Image size 1240x1240 · pediatric wide-field fundus photograph
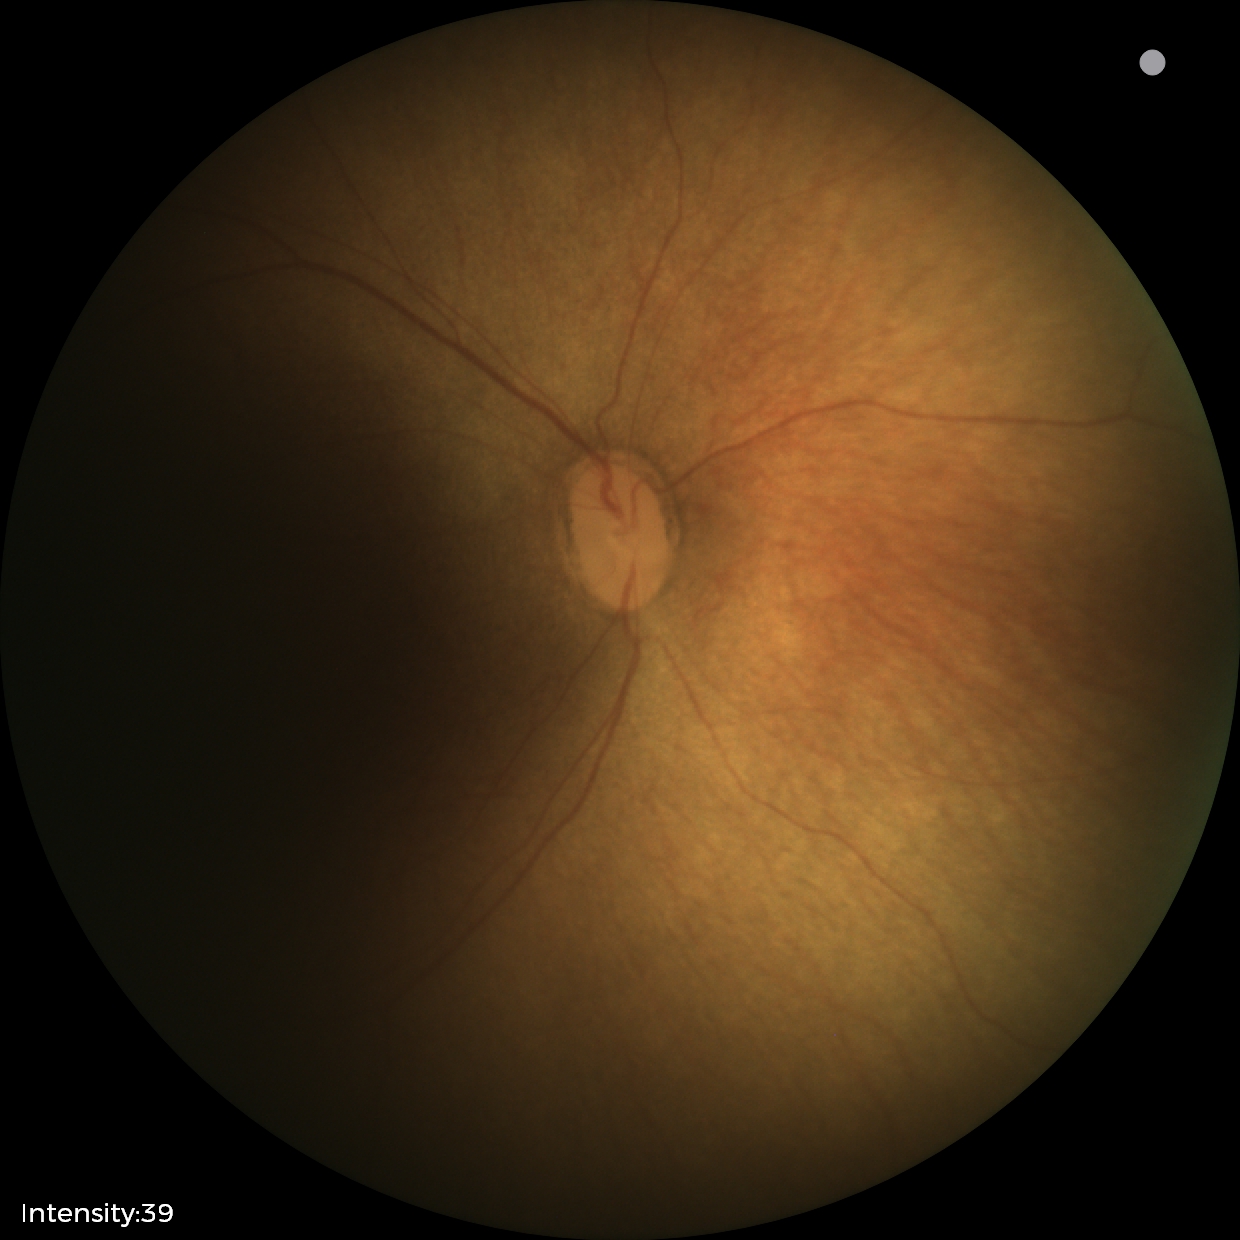

Physiological retinal appearance for postconceptual age.